1659x2212 — 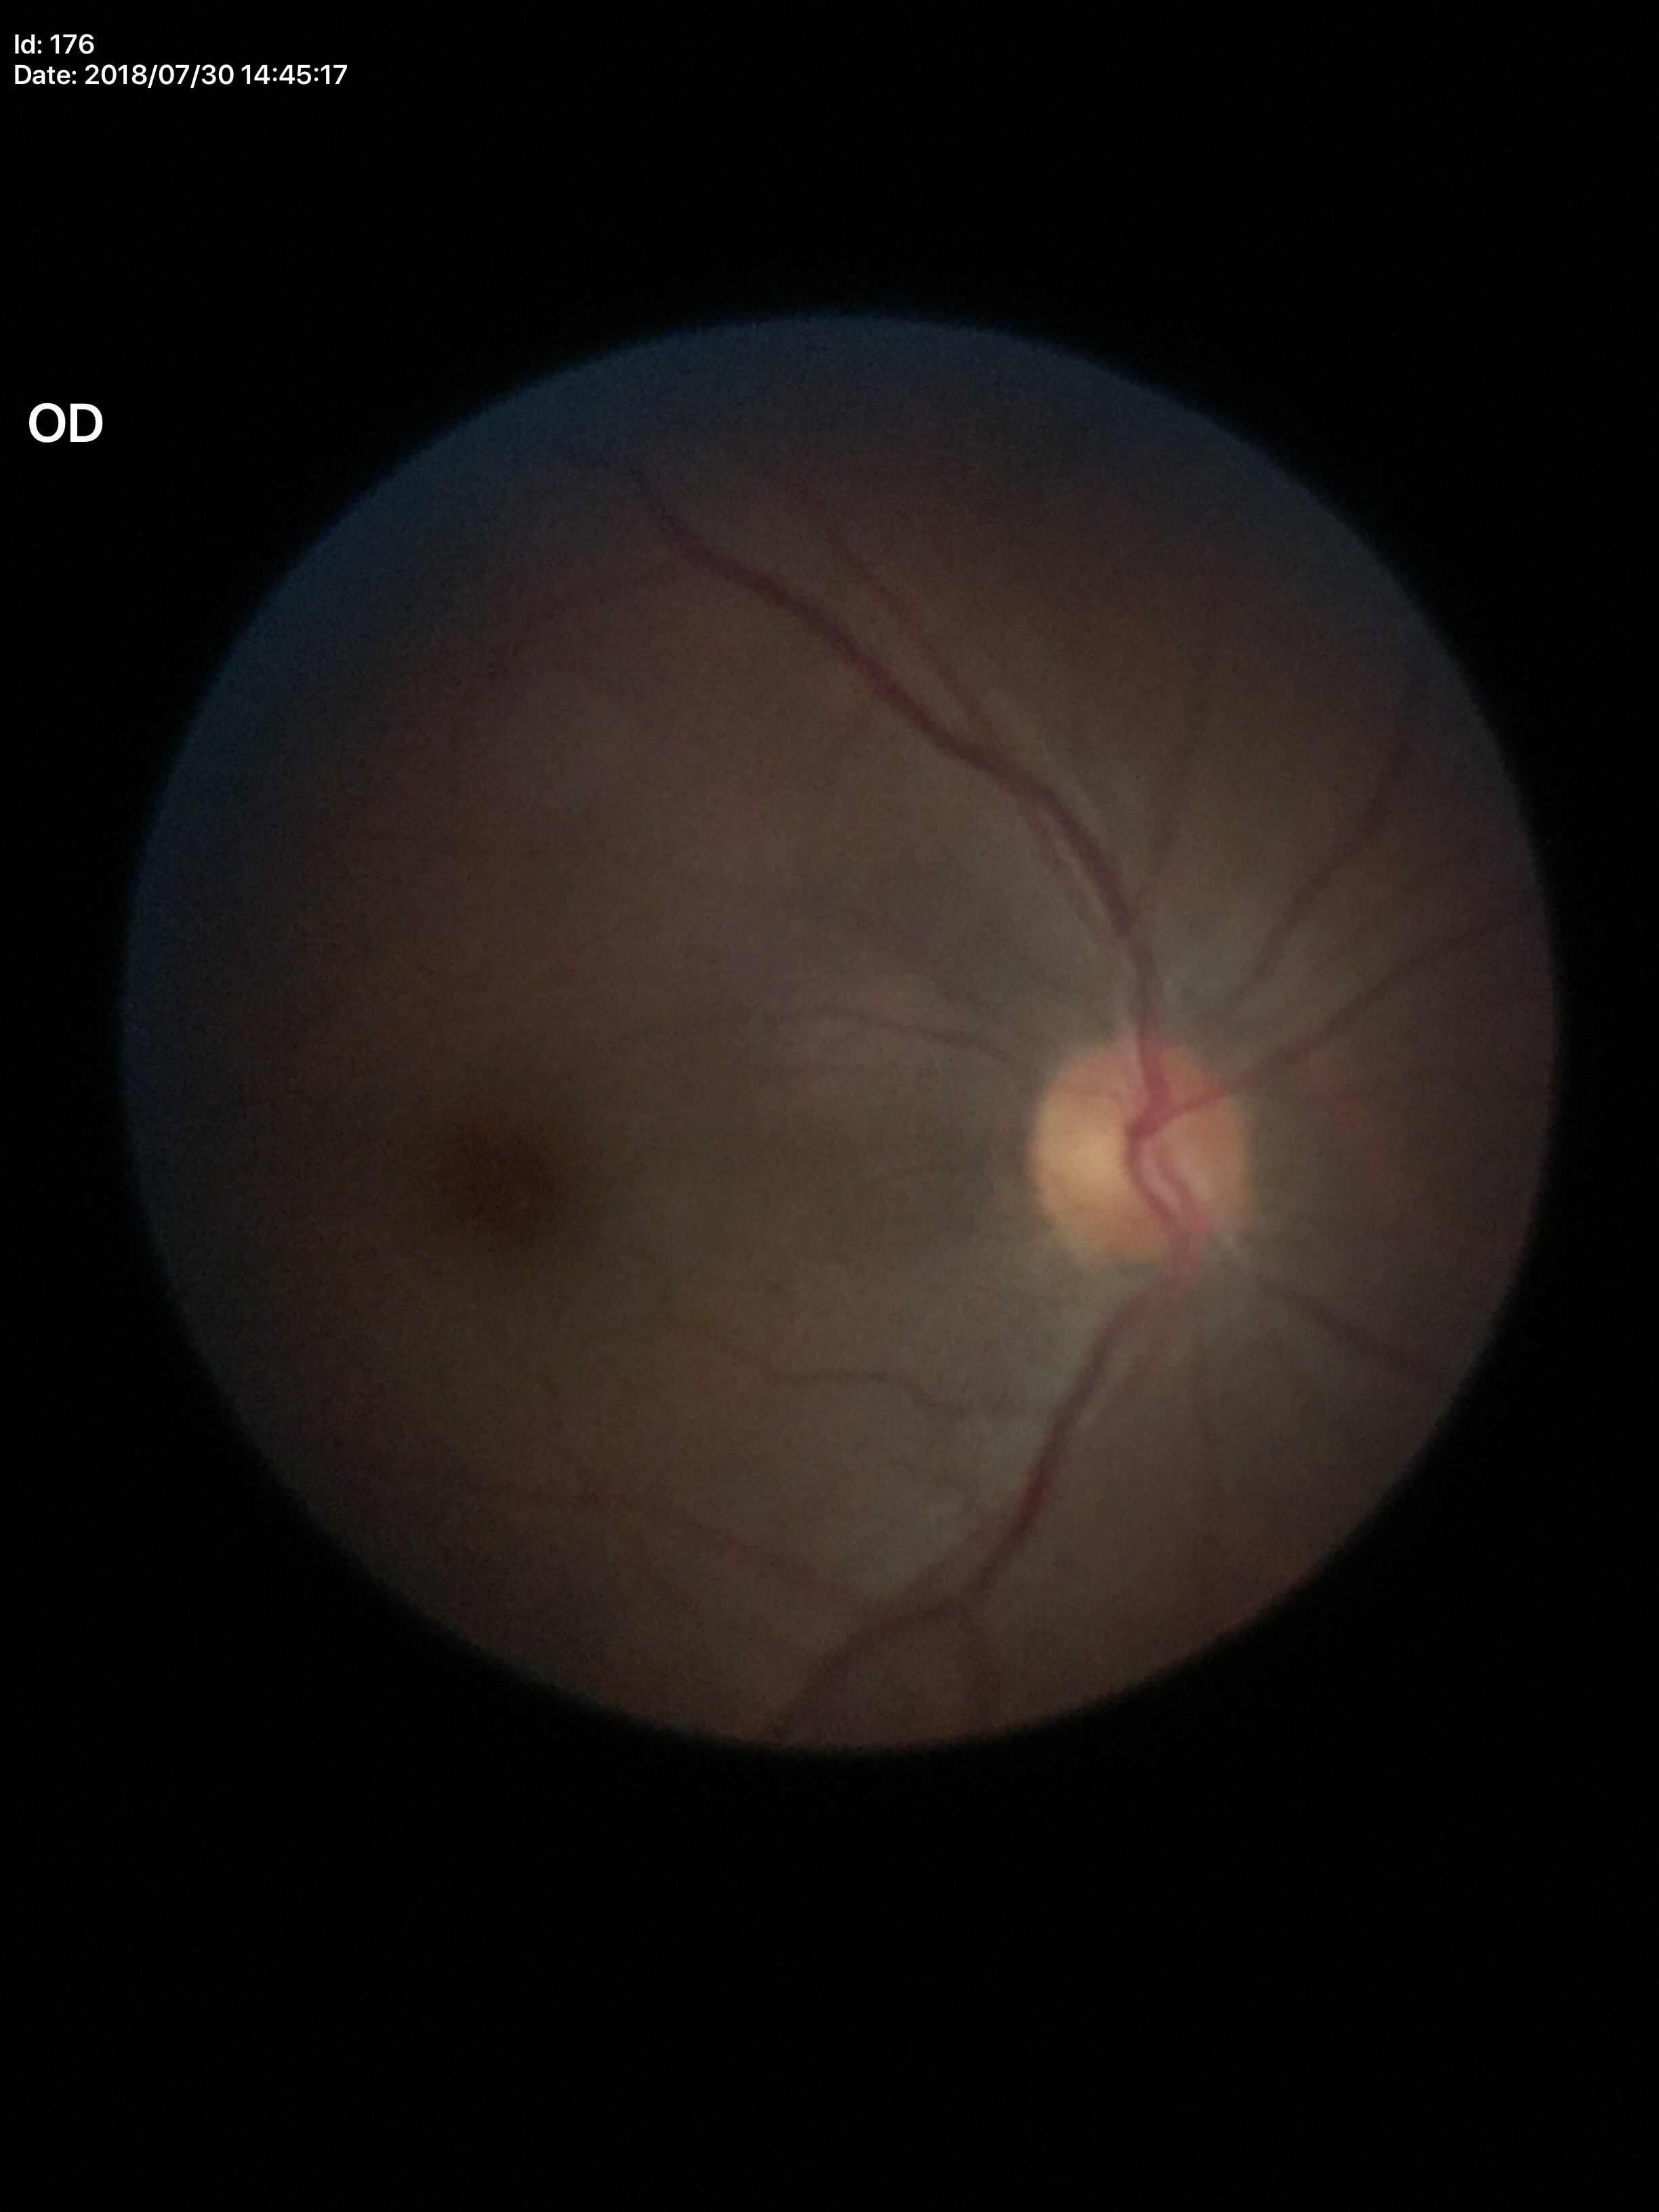

vertical cup-to-disc ratio = 0.48, Glaucoma screening = no suspicious findings (5/5 ophthalmologists in agreement).